Image size 2212x1659, fundus photo: 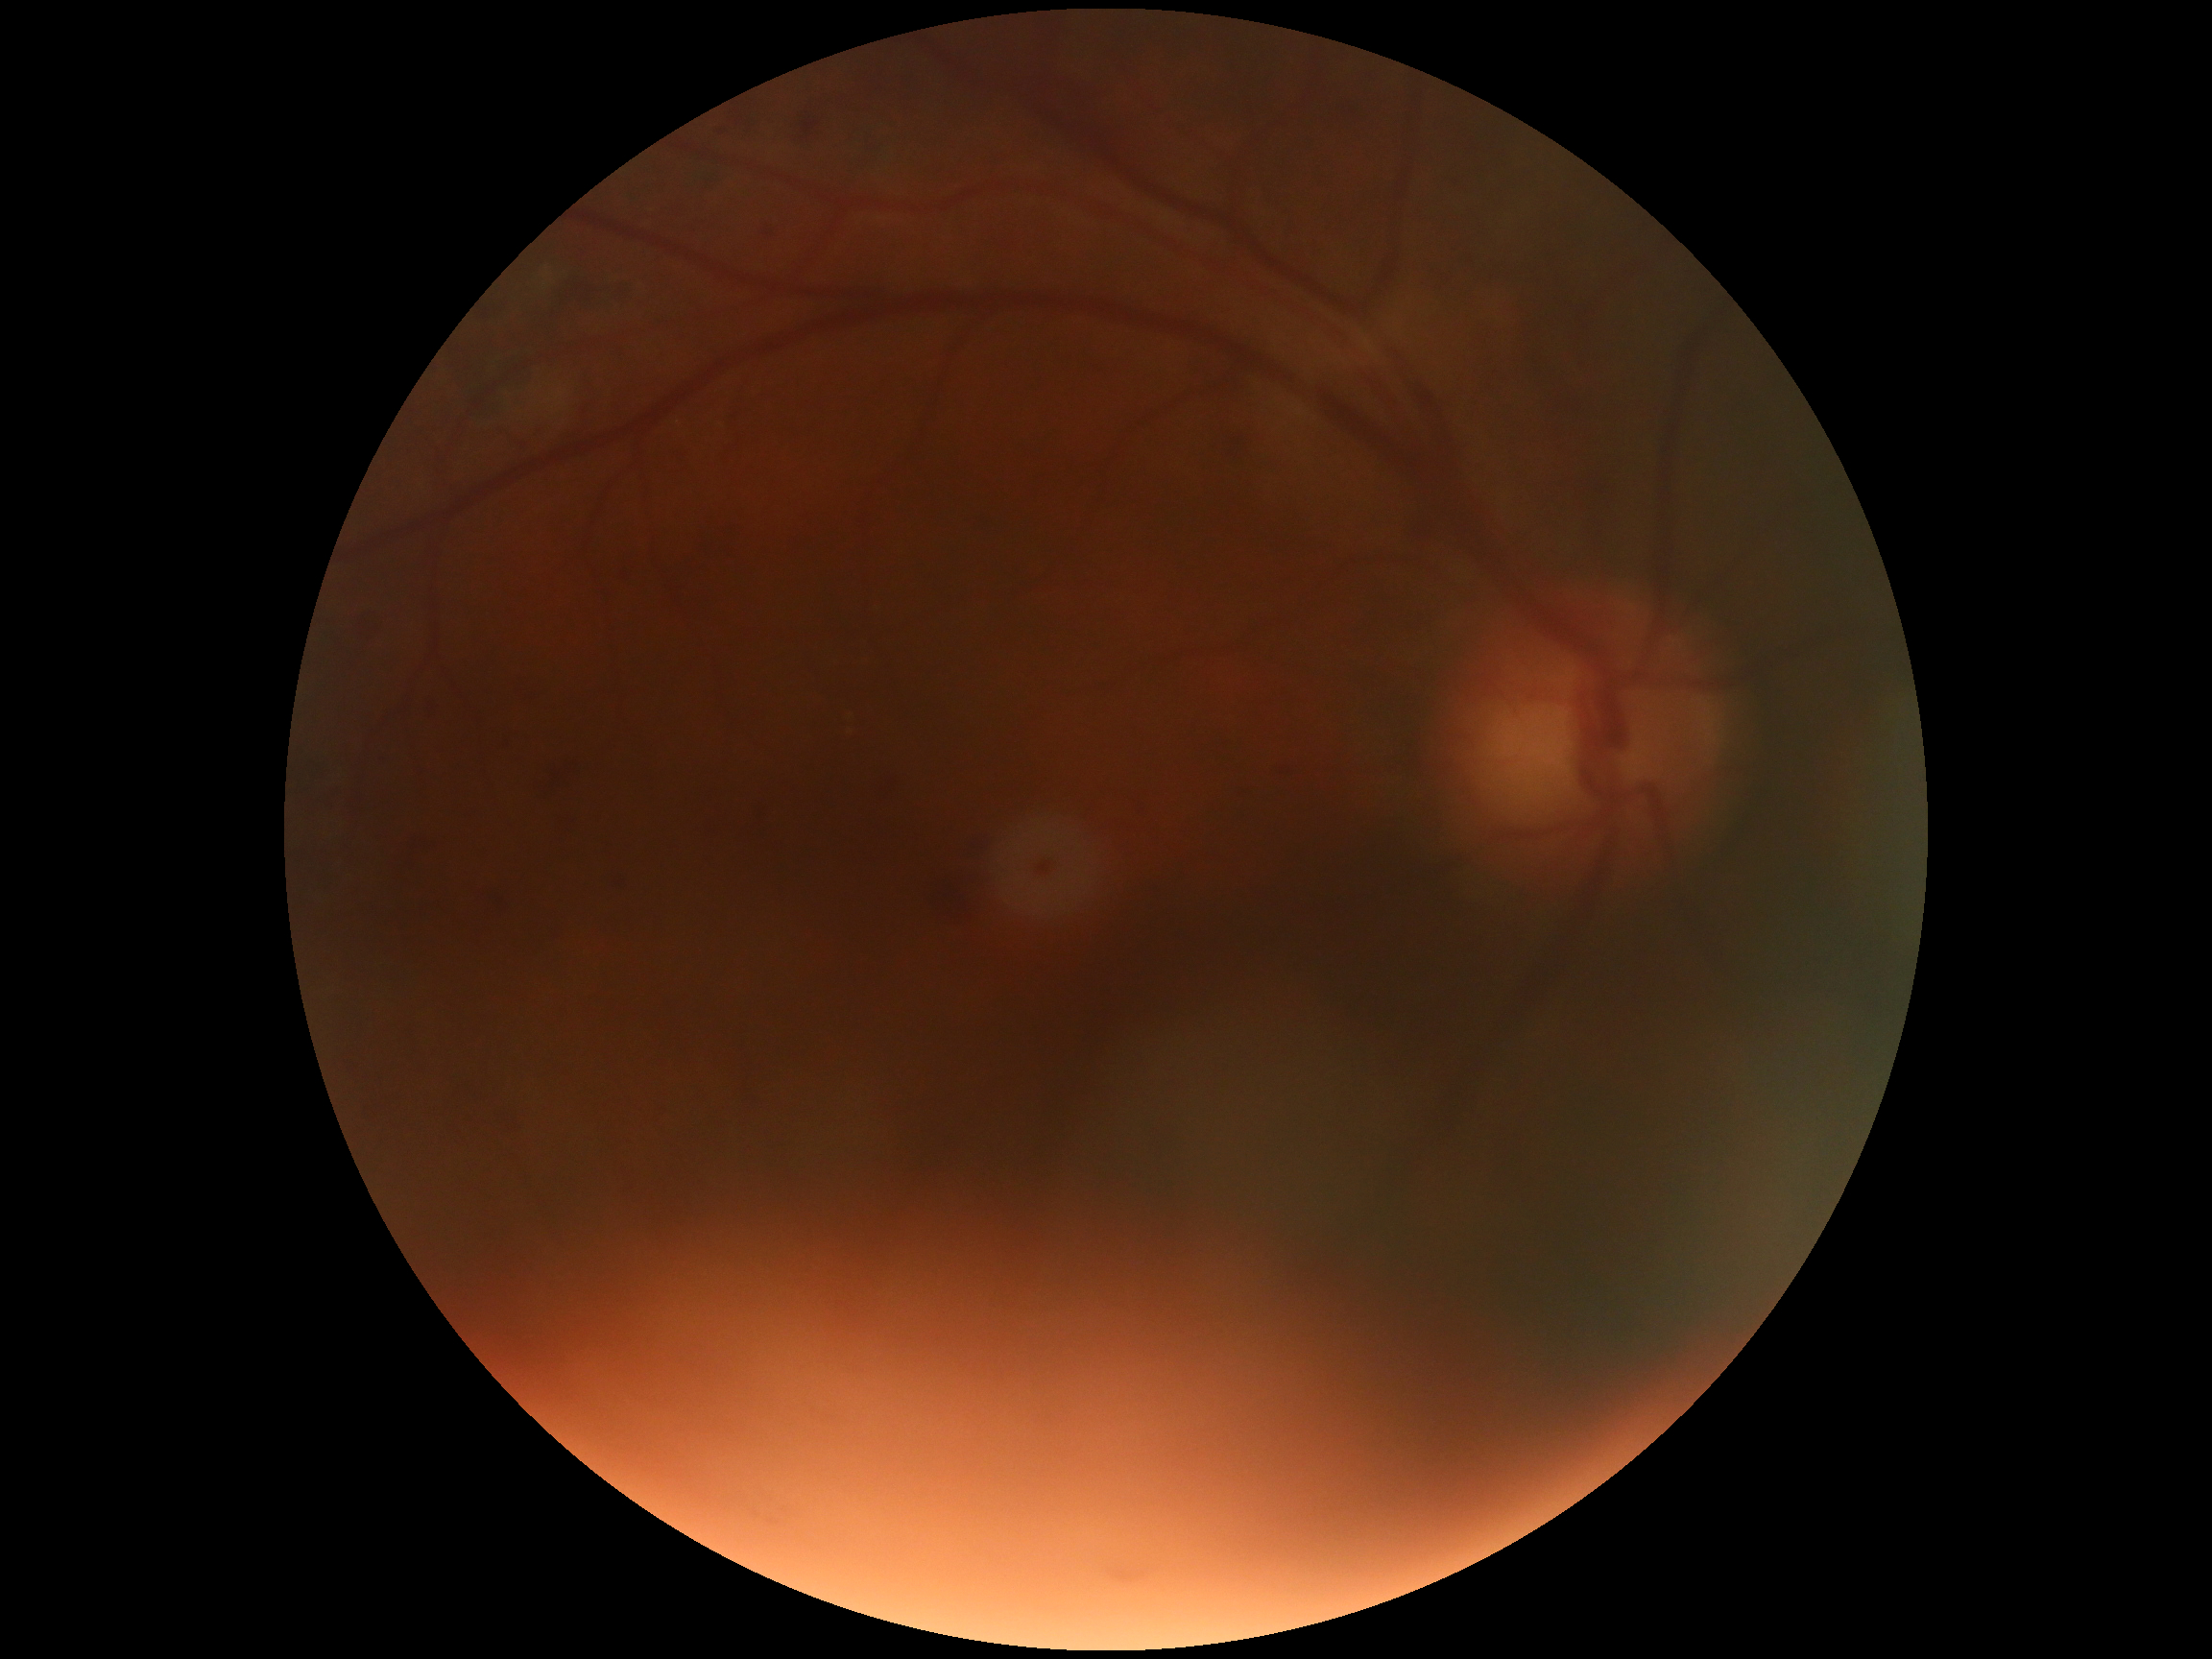
Annotations:
* DR — grade 2 (moderate NPDR)
* DR class — non-proliferative diabetic retinopathy